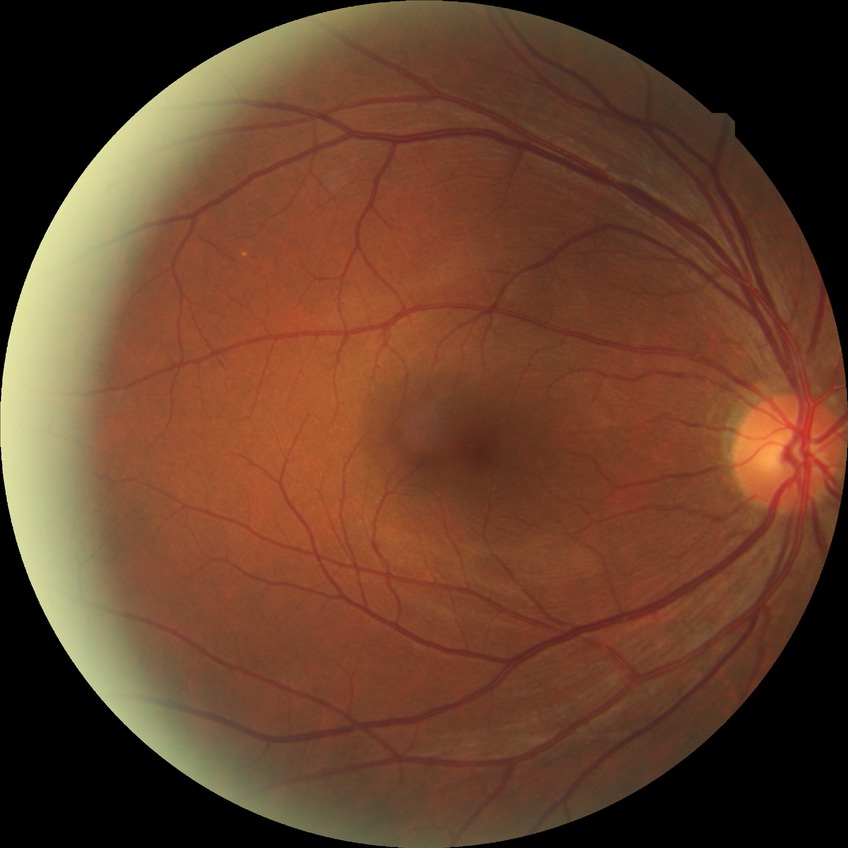
diabetic retinopathy grade: no diabetic retinopathy.